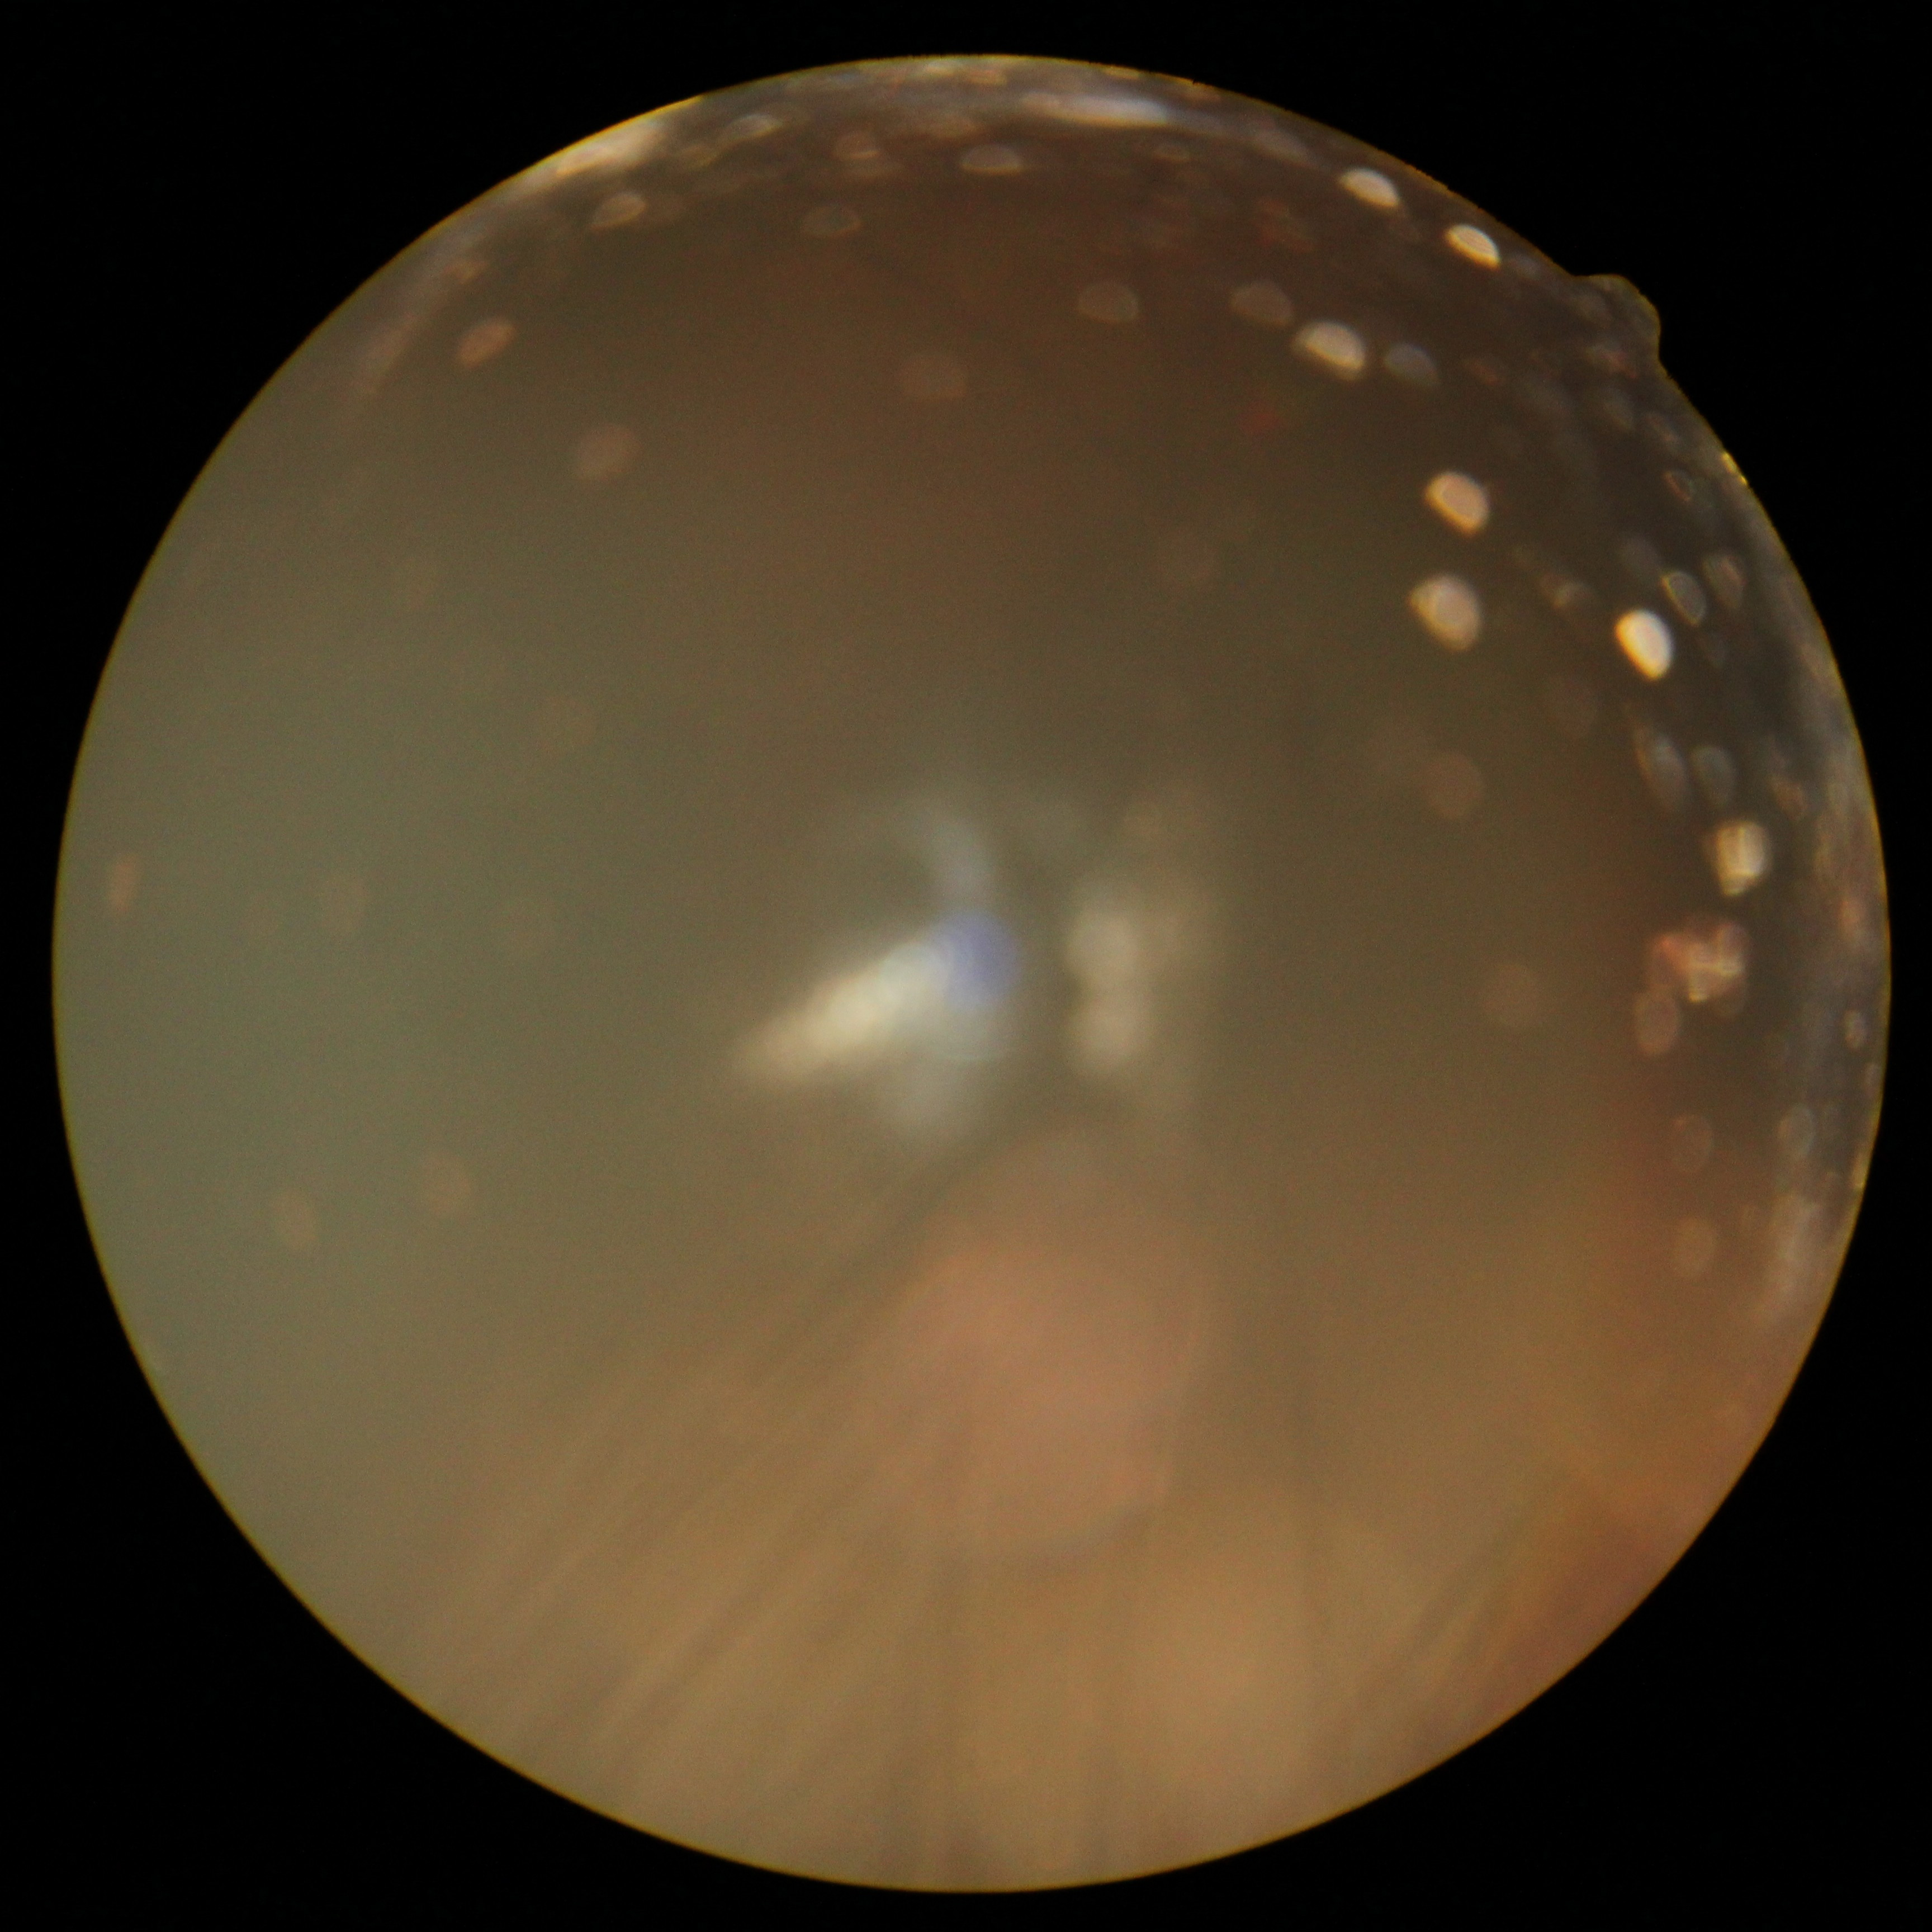 {"dr_grade": "ungradable", "quality": "insufficient"}